45° FOV:
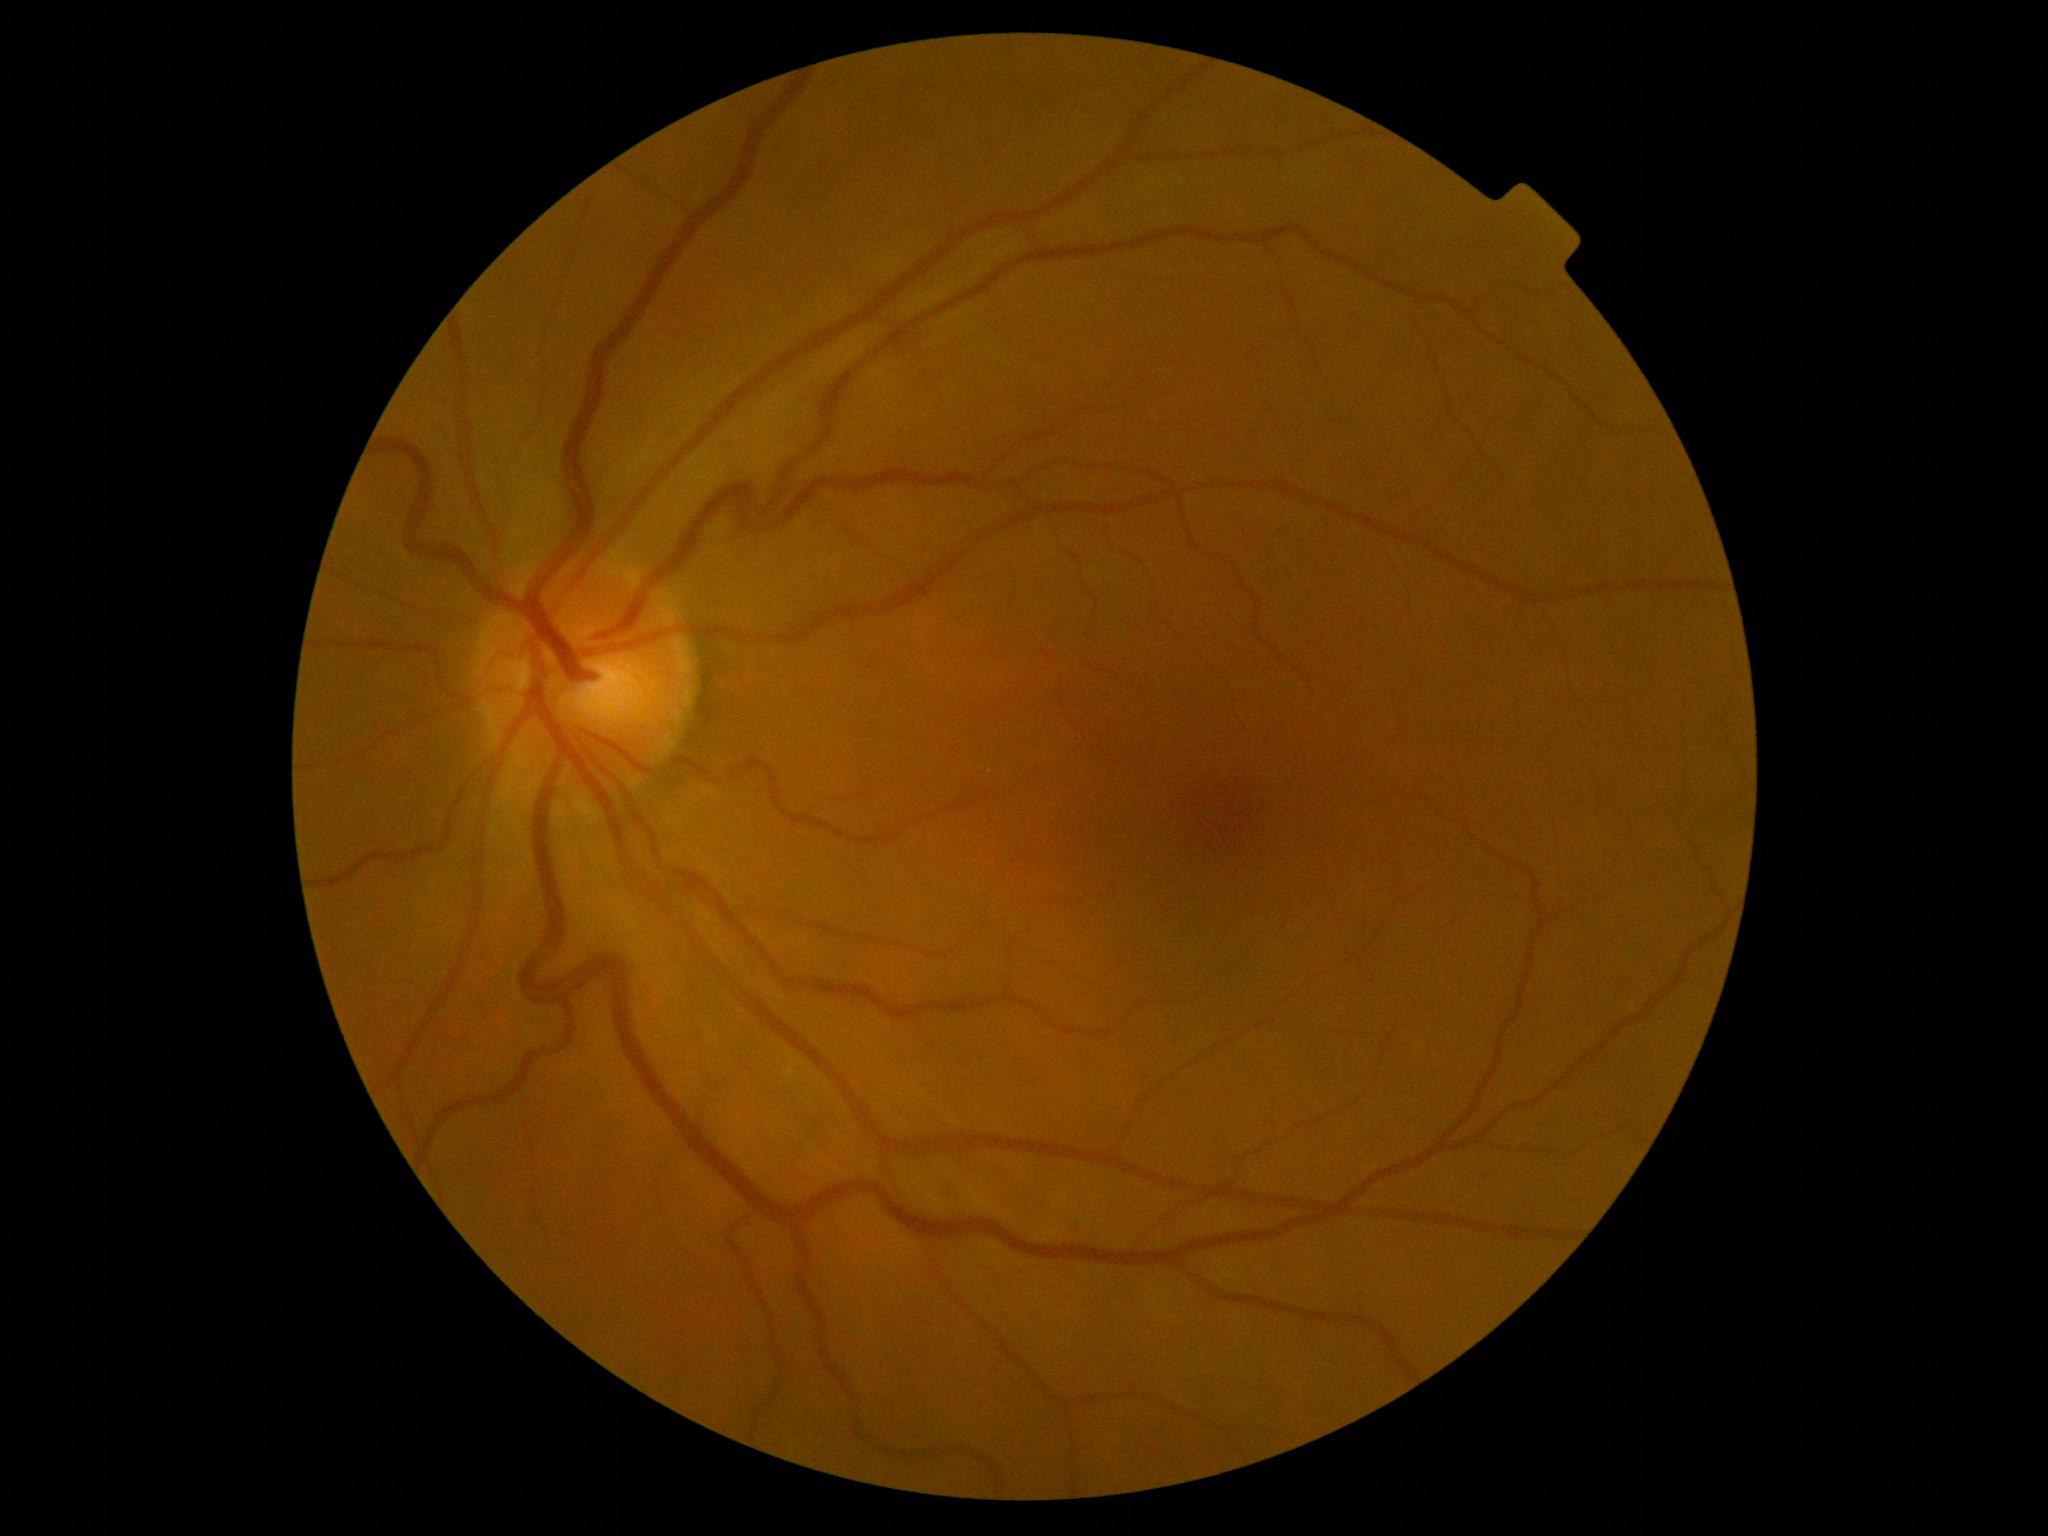 DR grade is 0. No signs of diabetic retinopathy.